Retinal fundus photograph · 412x310px
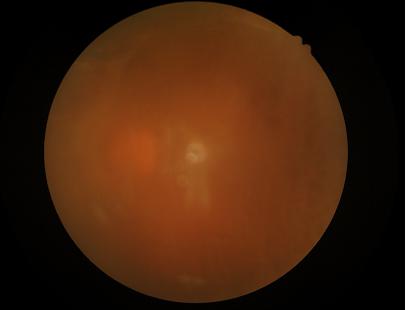 overall_quality: poor
clarity: blurry
illumination: poor
contrast: low